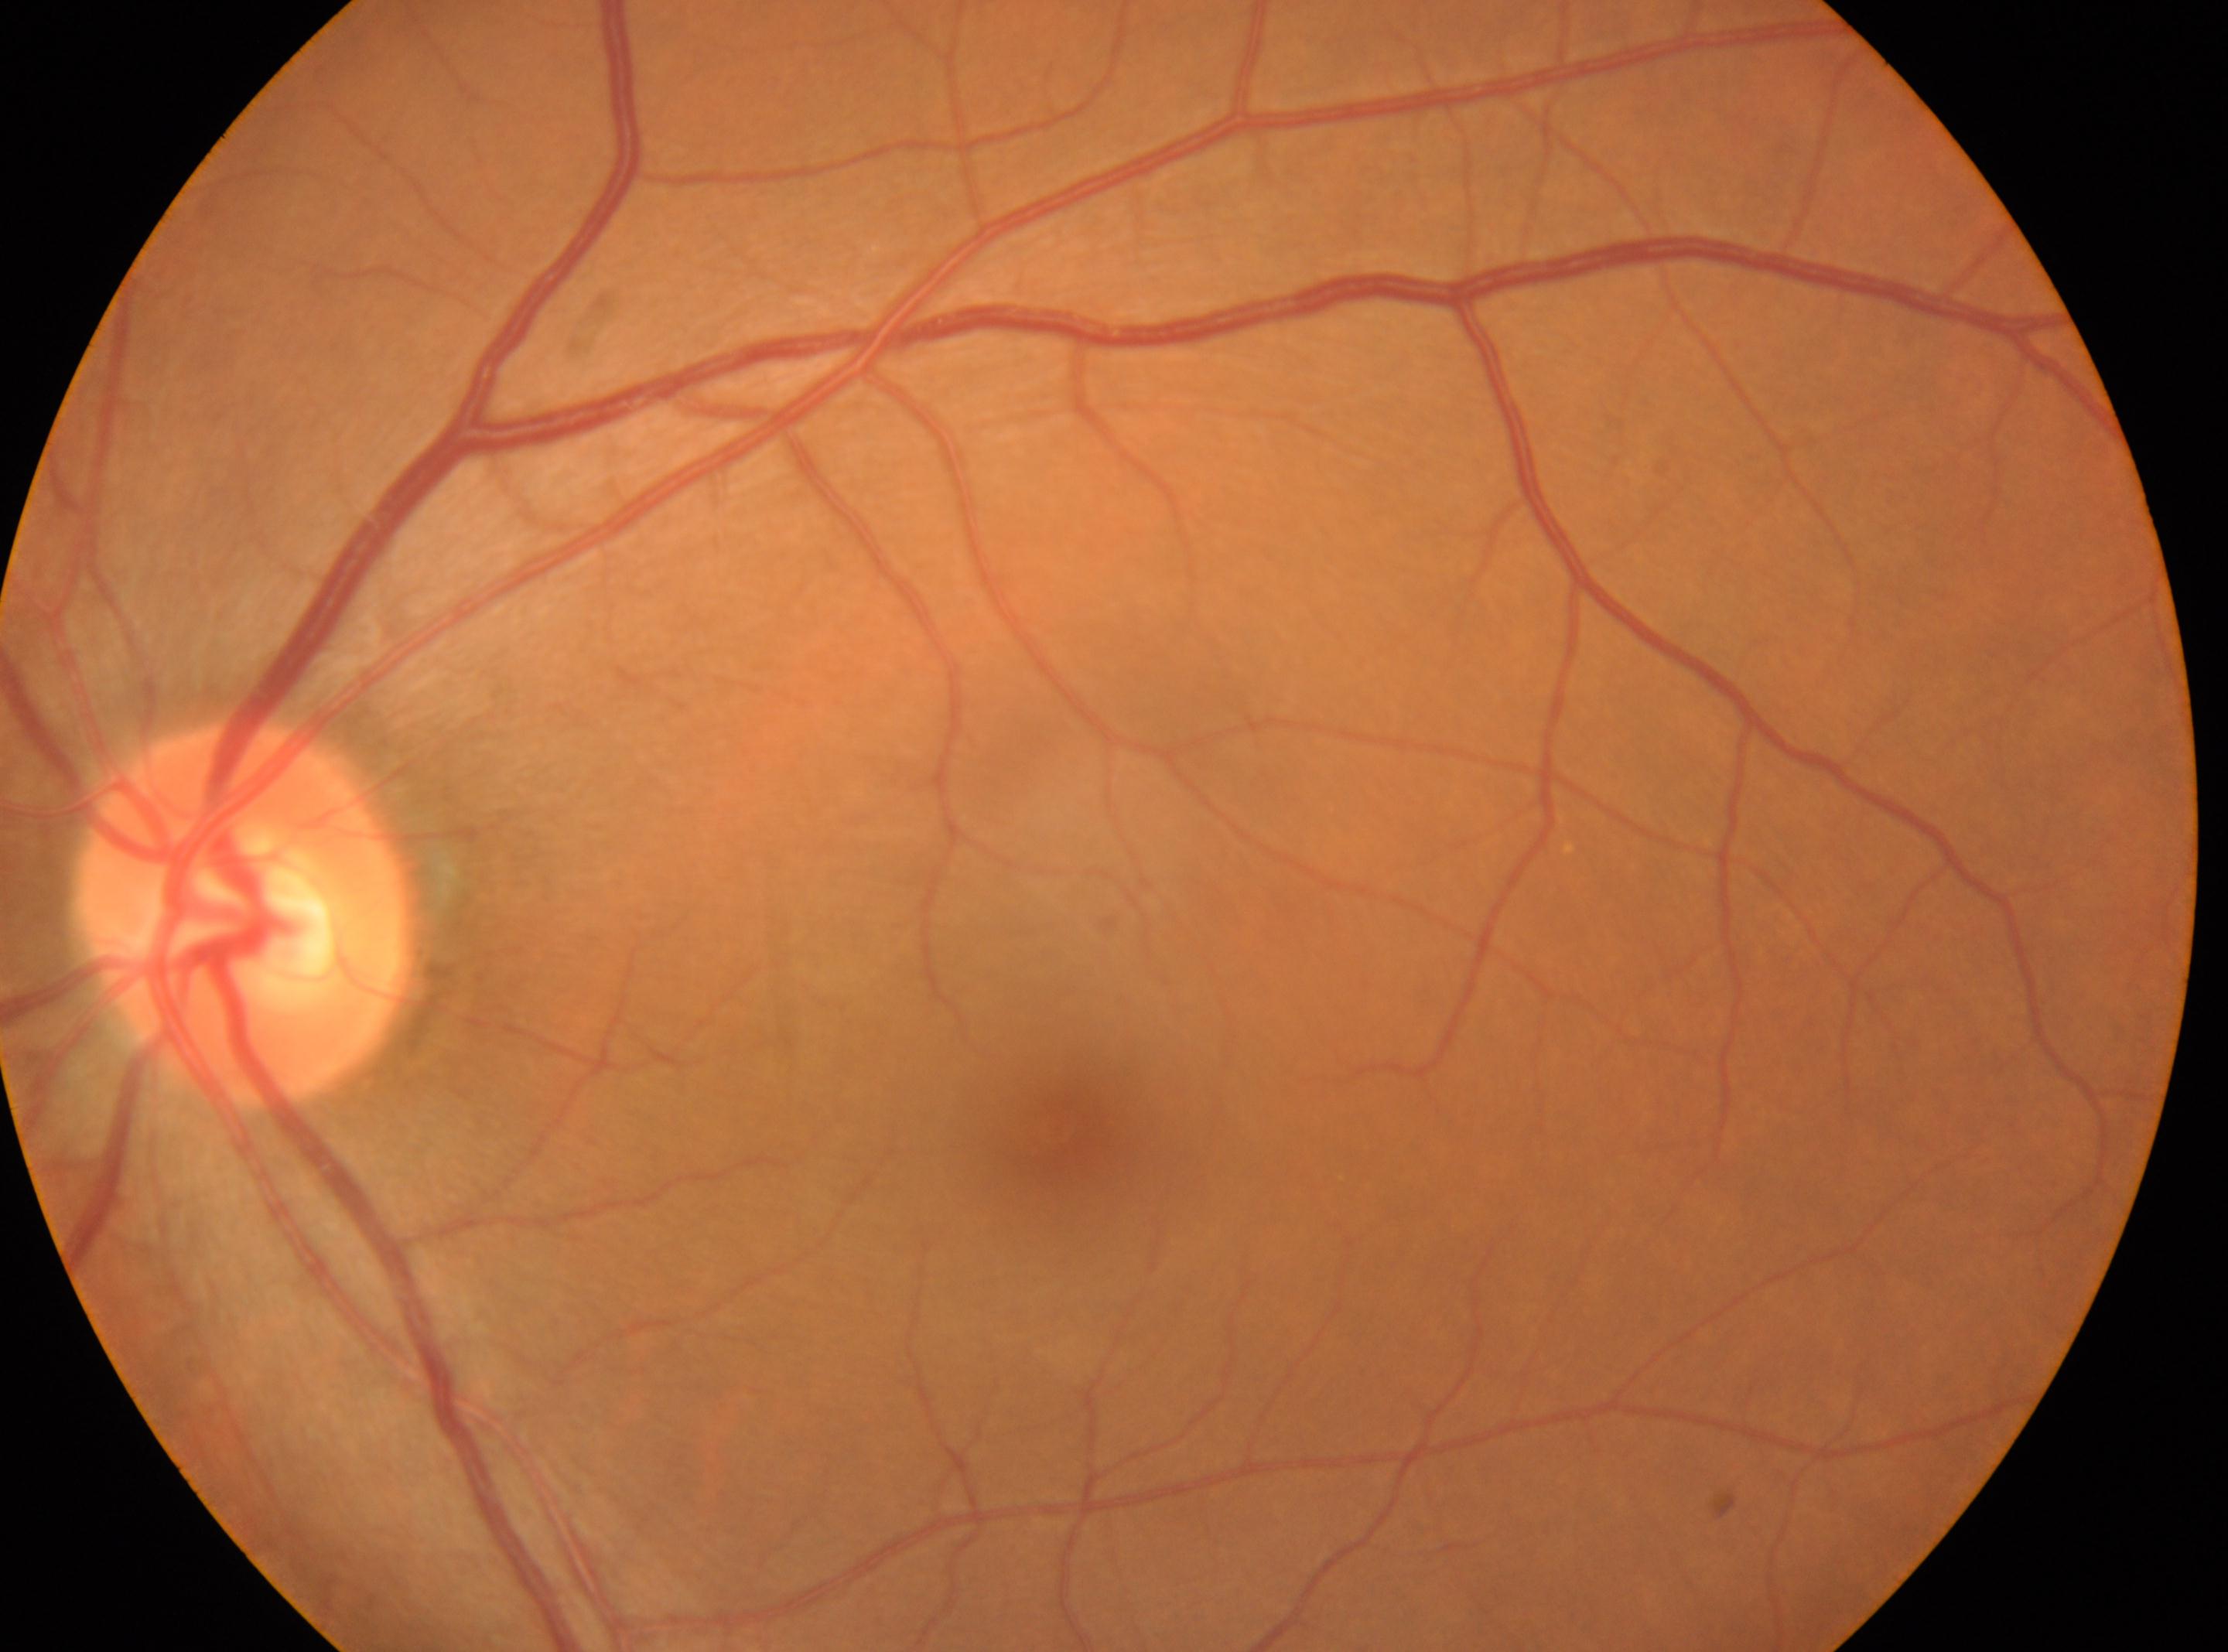
Fovea center located at (1057, 1129).
This is the OS.
Diabetic retinopathy (DR) is grade 0.
The ONH is at (246, 914).